Graded on the modified Davis scale:
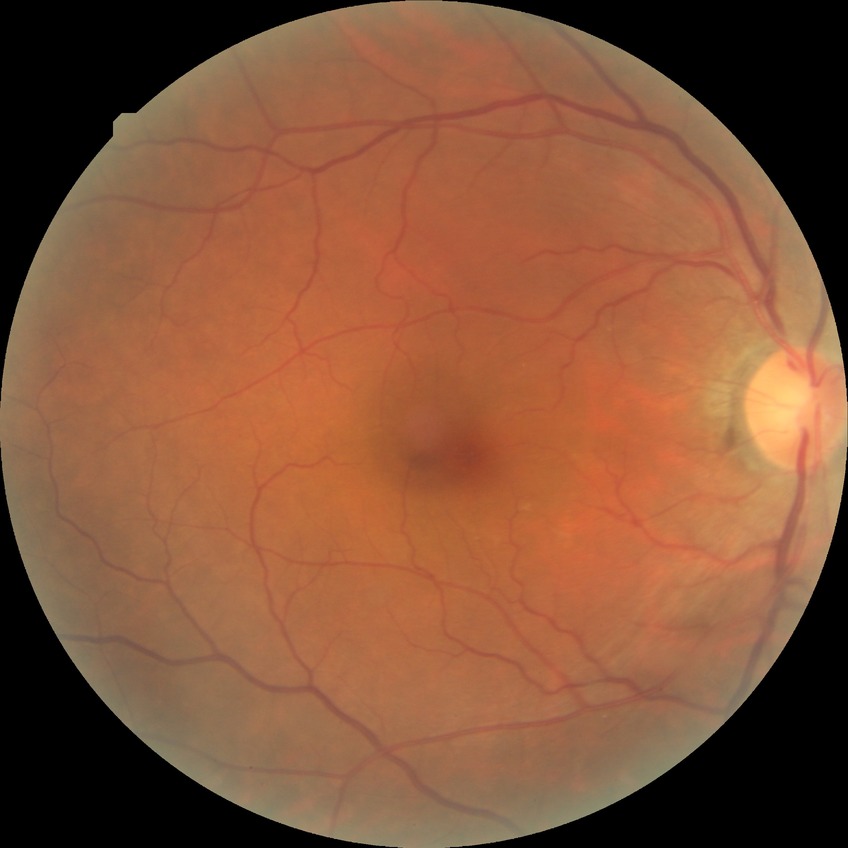
Diabetic retinopathy (DR): no diabetic retinopathy (NDR).